FOV: 45 degrees.
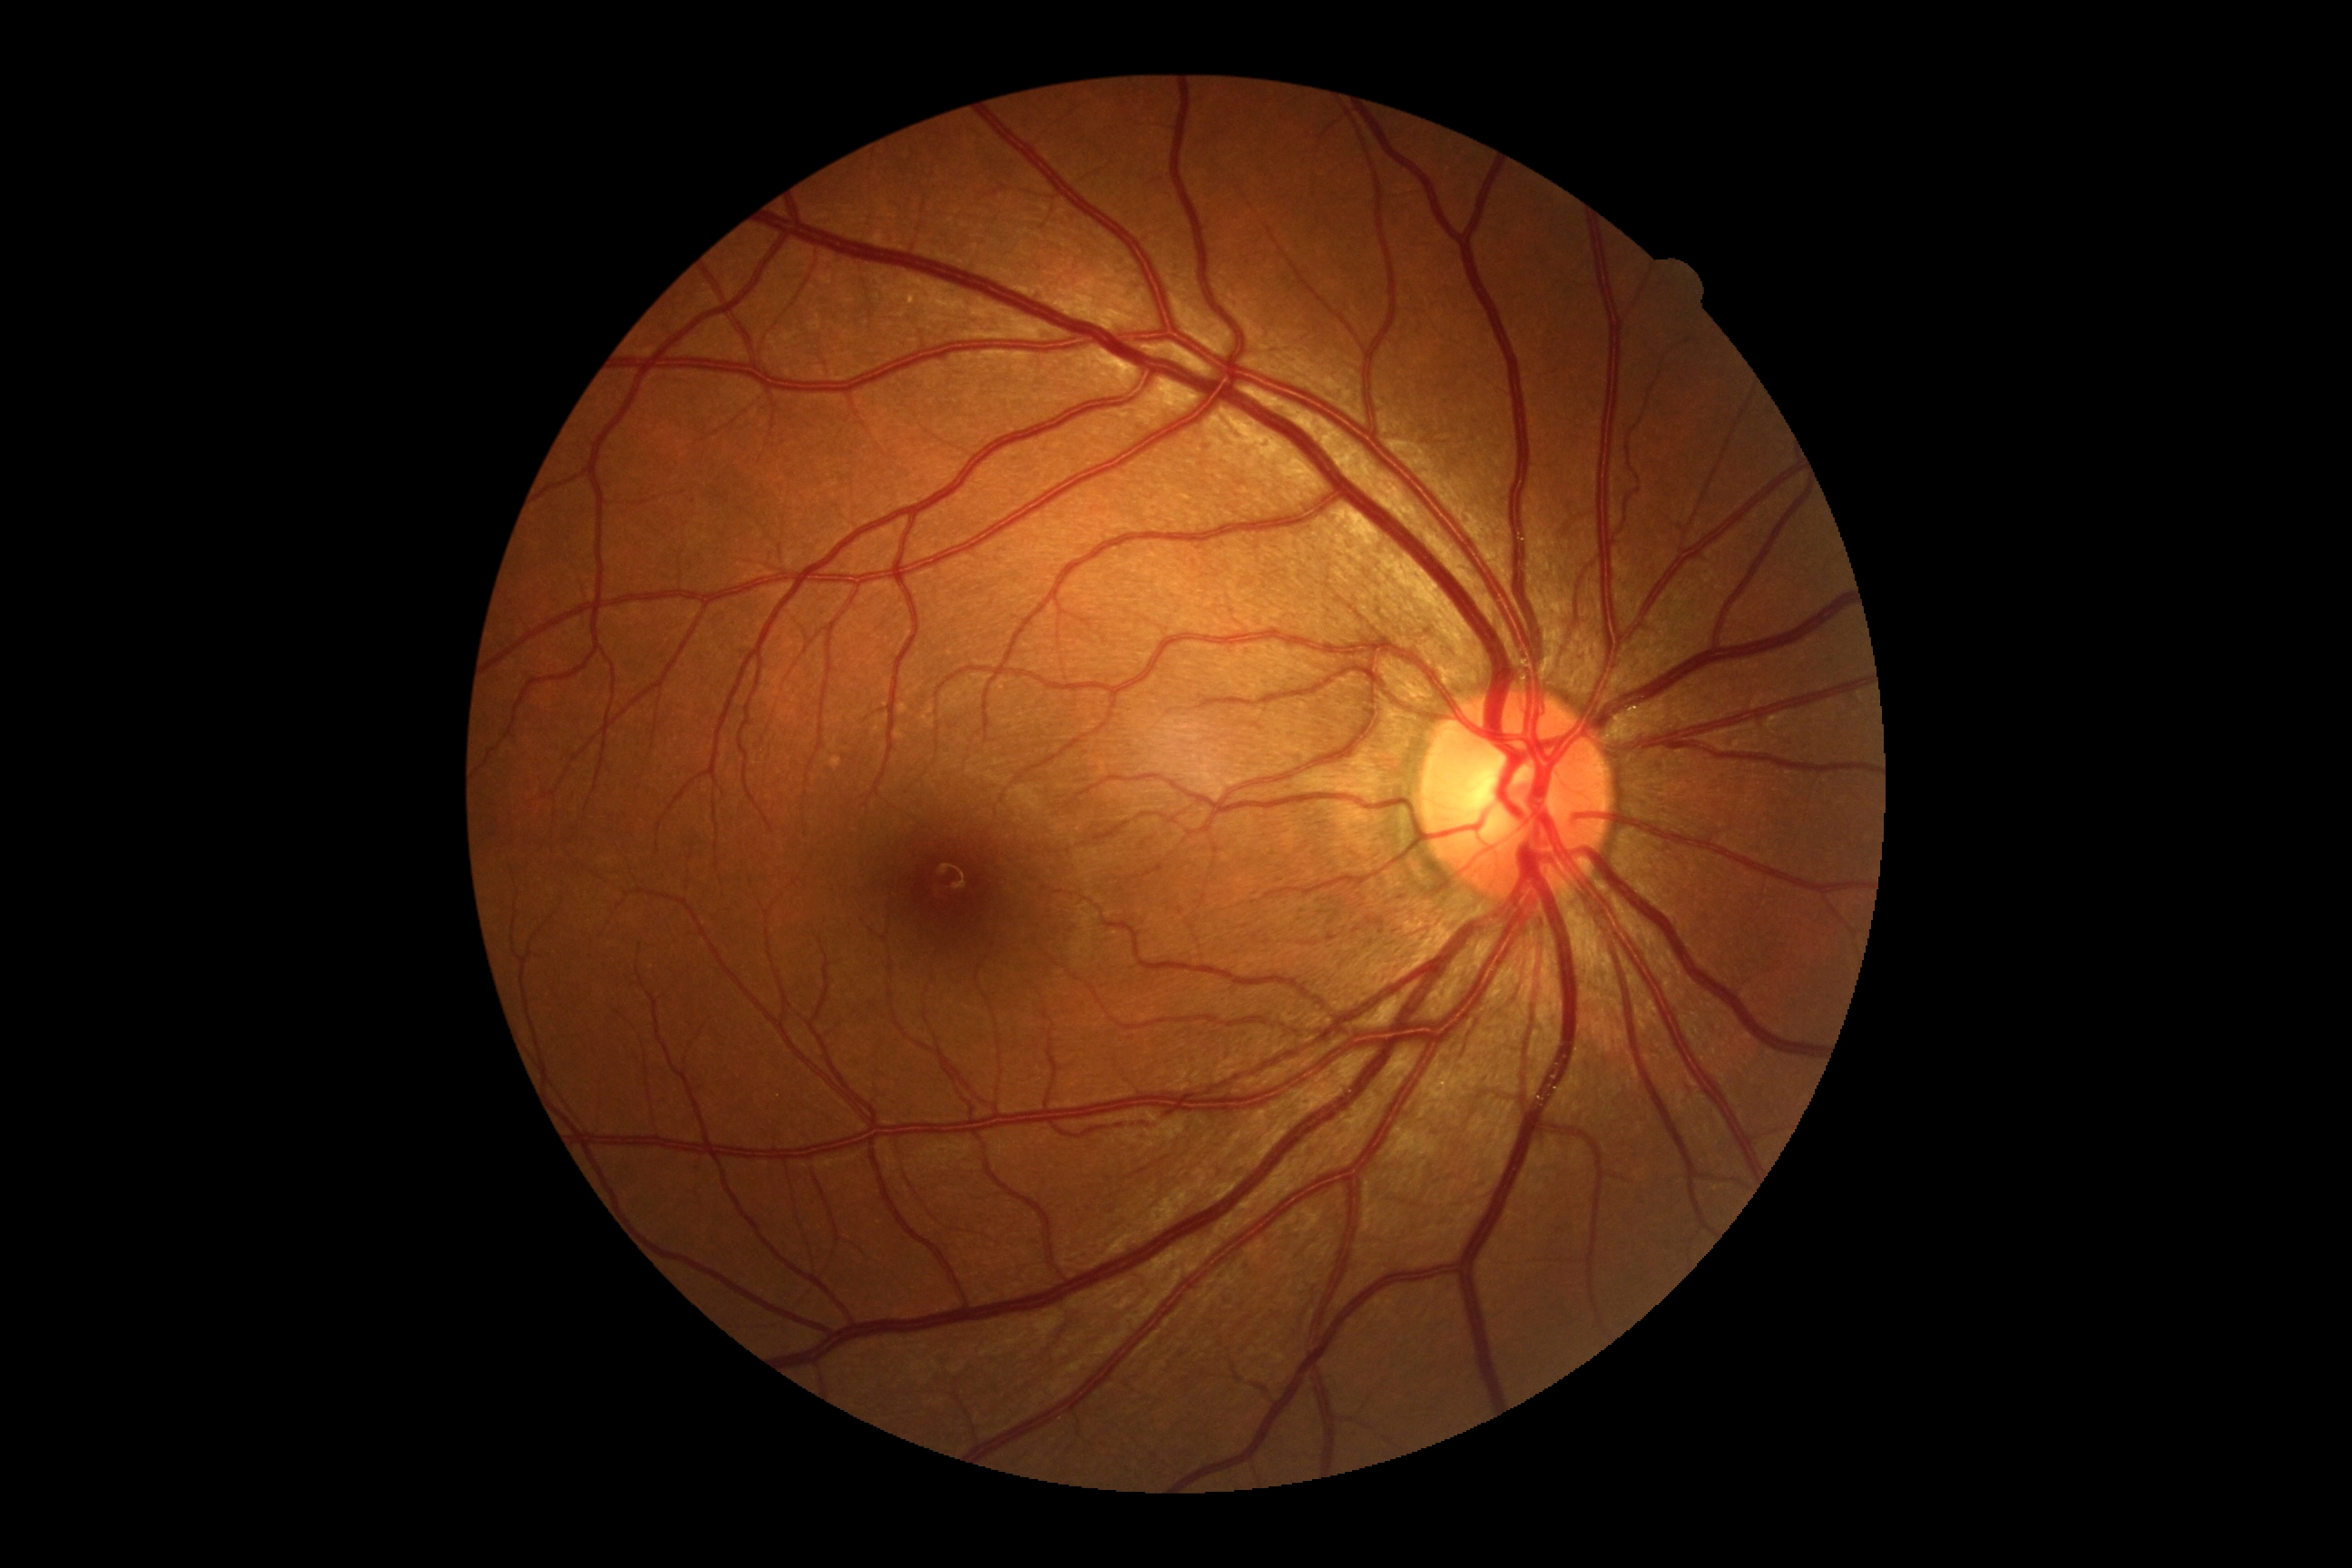

DR: grade 0 (no apparent retinopathy).